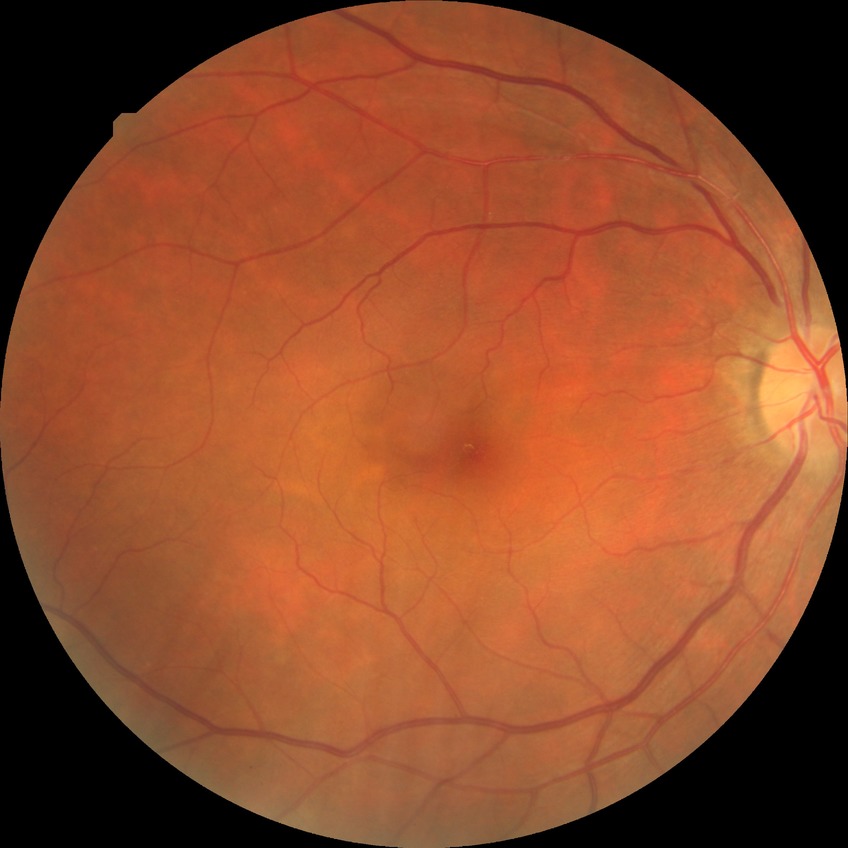
Diabetic retinopathy (DR): no diabetic retinopathy (NDR).